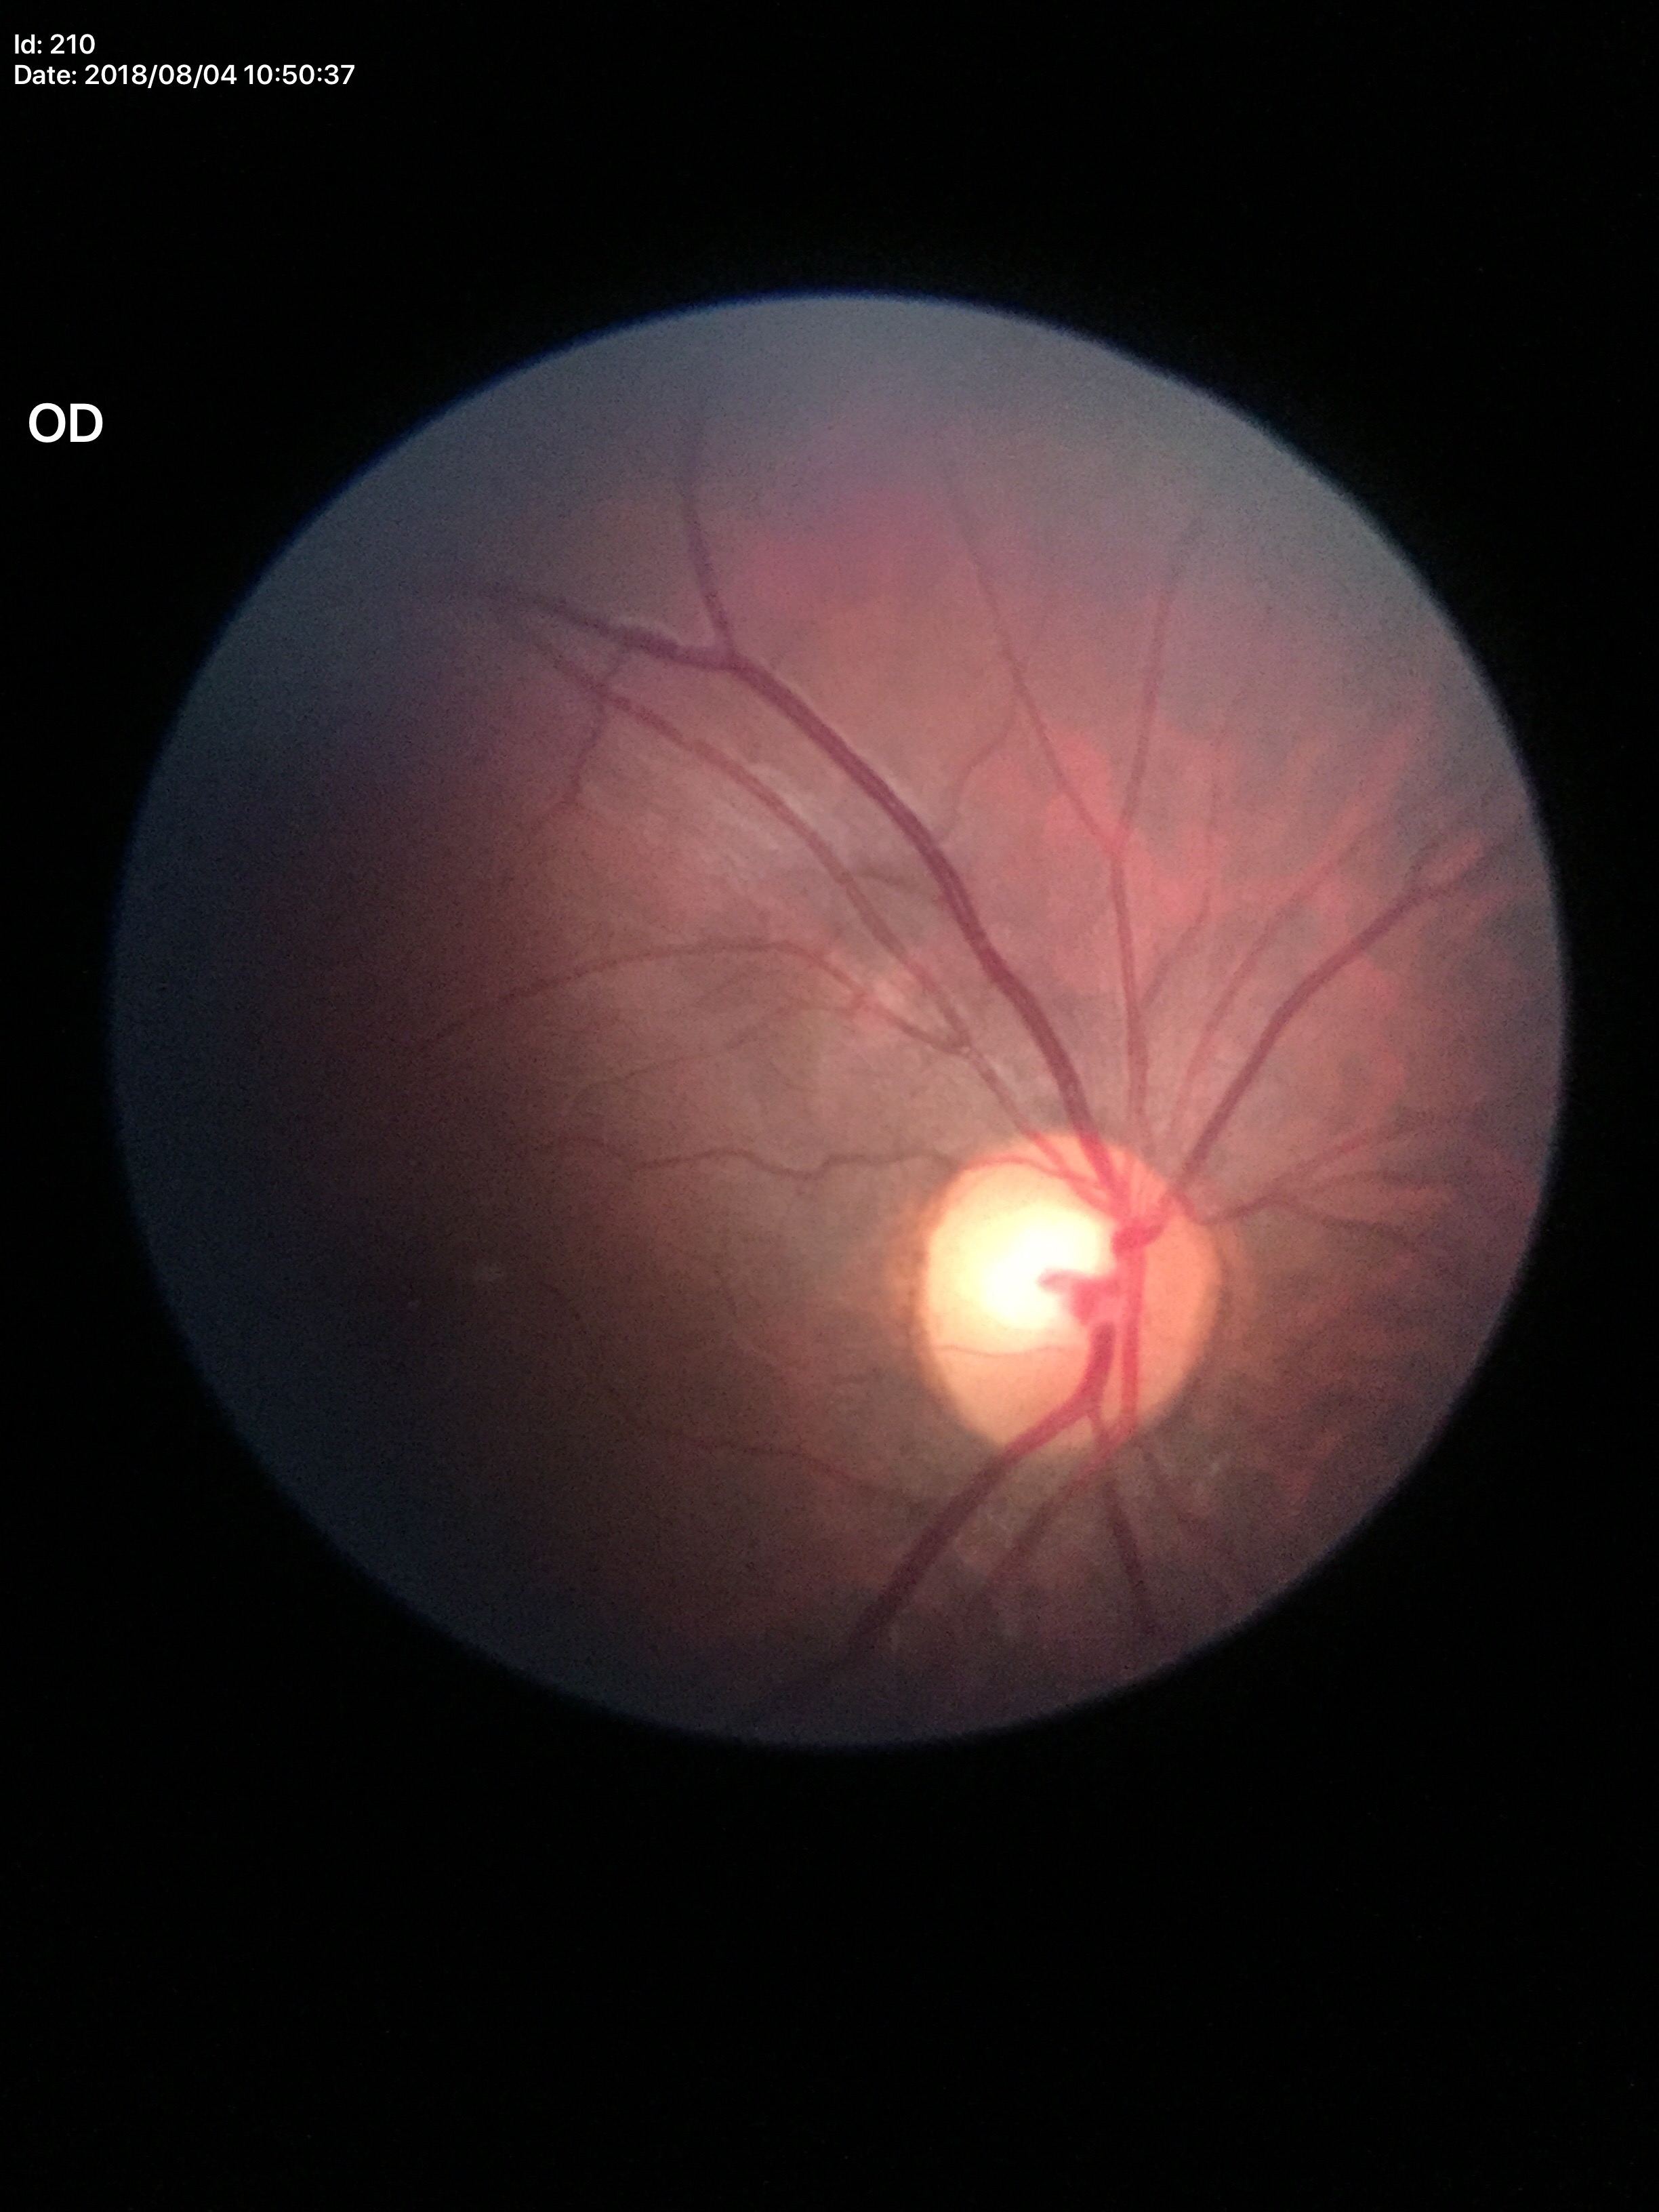 vertical C/D ratio (VCDR)=0.50 | horizontal C/D ratio (HCDR)=0.64 | Glaucoma screening=not suspect